Modified Davis classification:
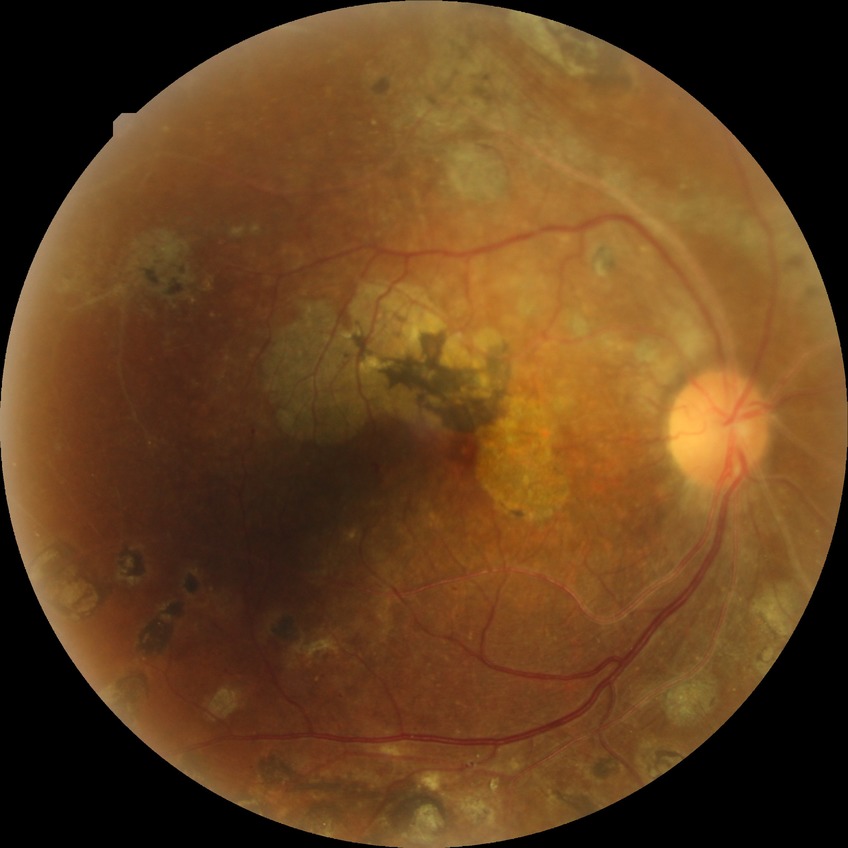 Davis grading is proliferative diabetic retinopathy.